45° FOV
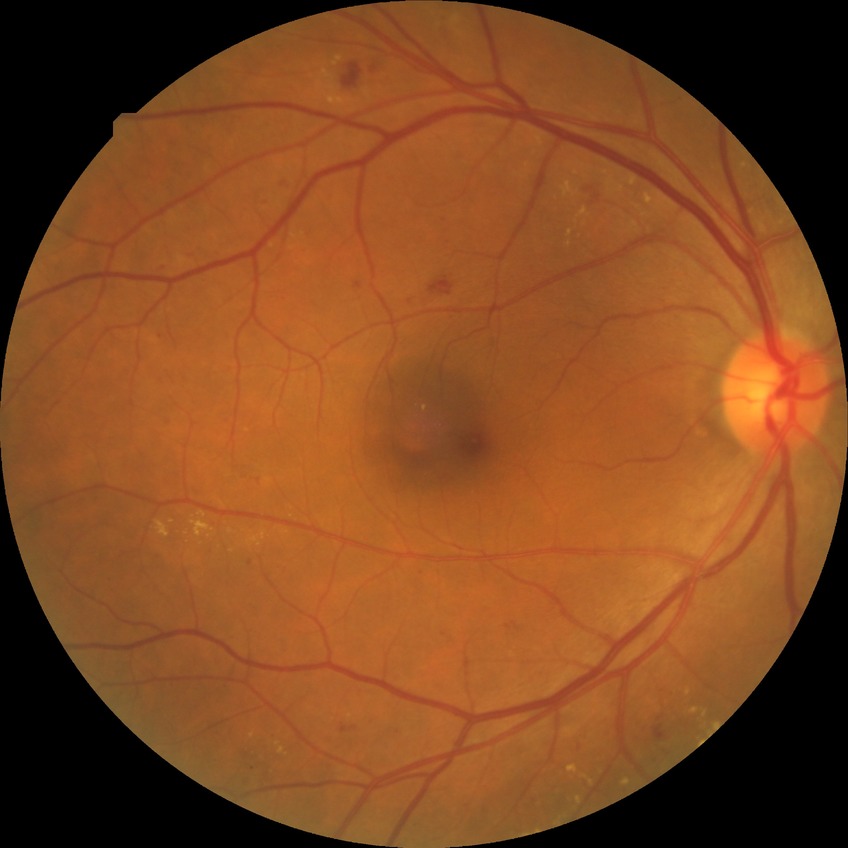

Diabetic retinopathy (DR): SDR (simple diabetic retinopathy).